Color fundus photograph — 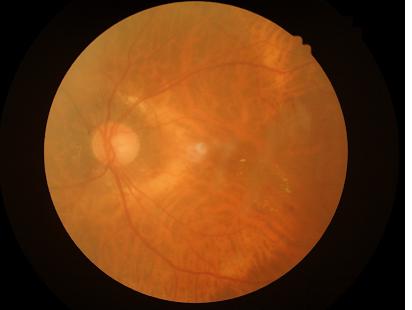 clarity: out of focus, structures indistinct
overall_quality: inadequate for clinical interpretation
contrast: good dynamic range